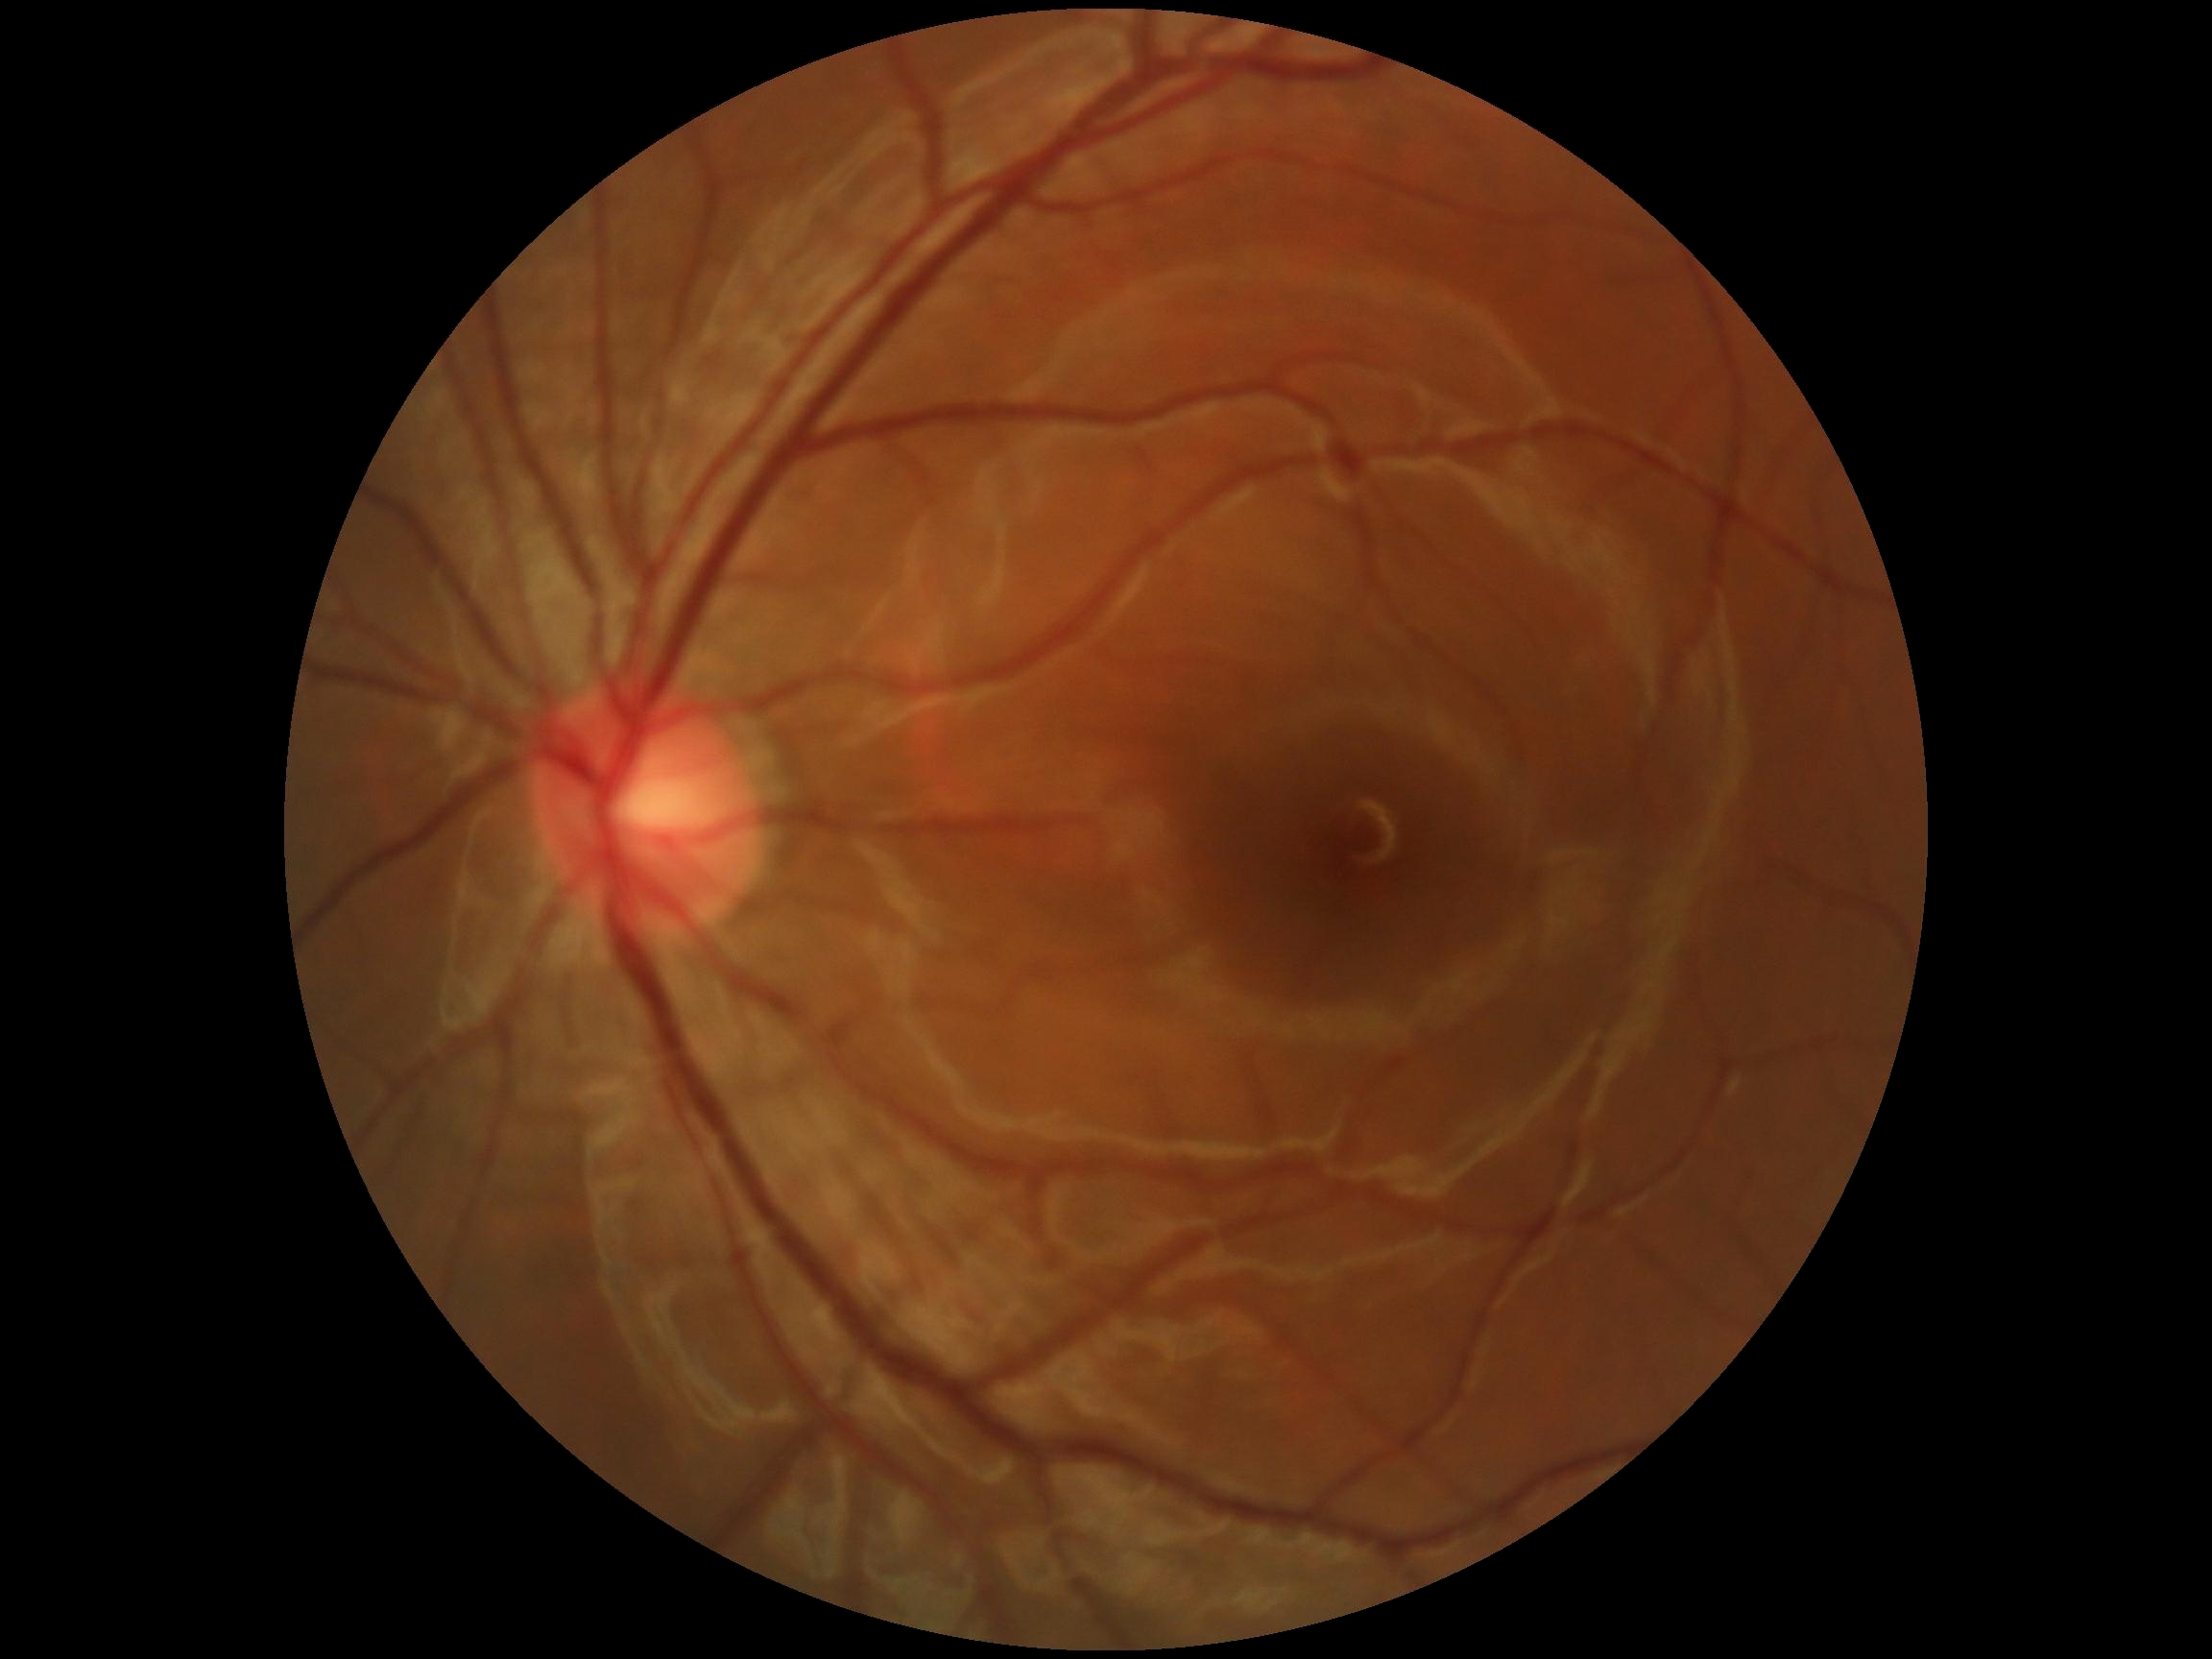 DR: 0/4; DR impression: no apparent DR.